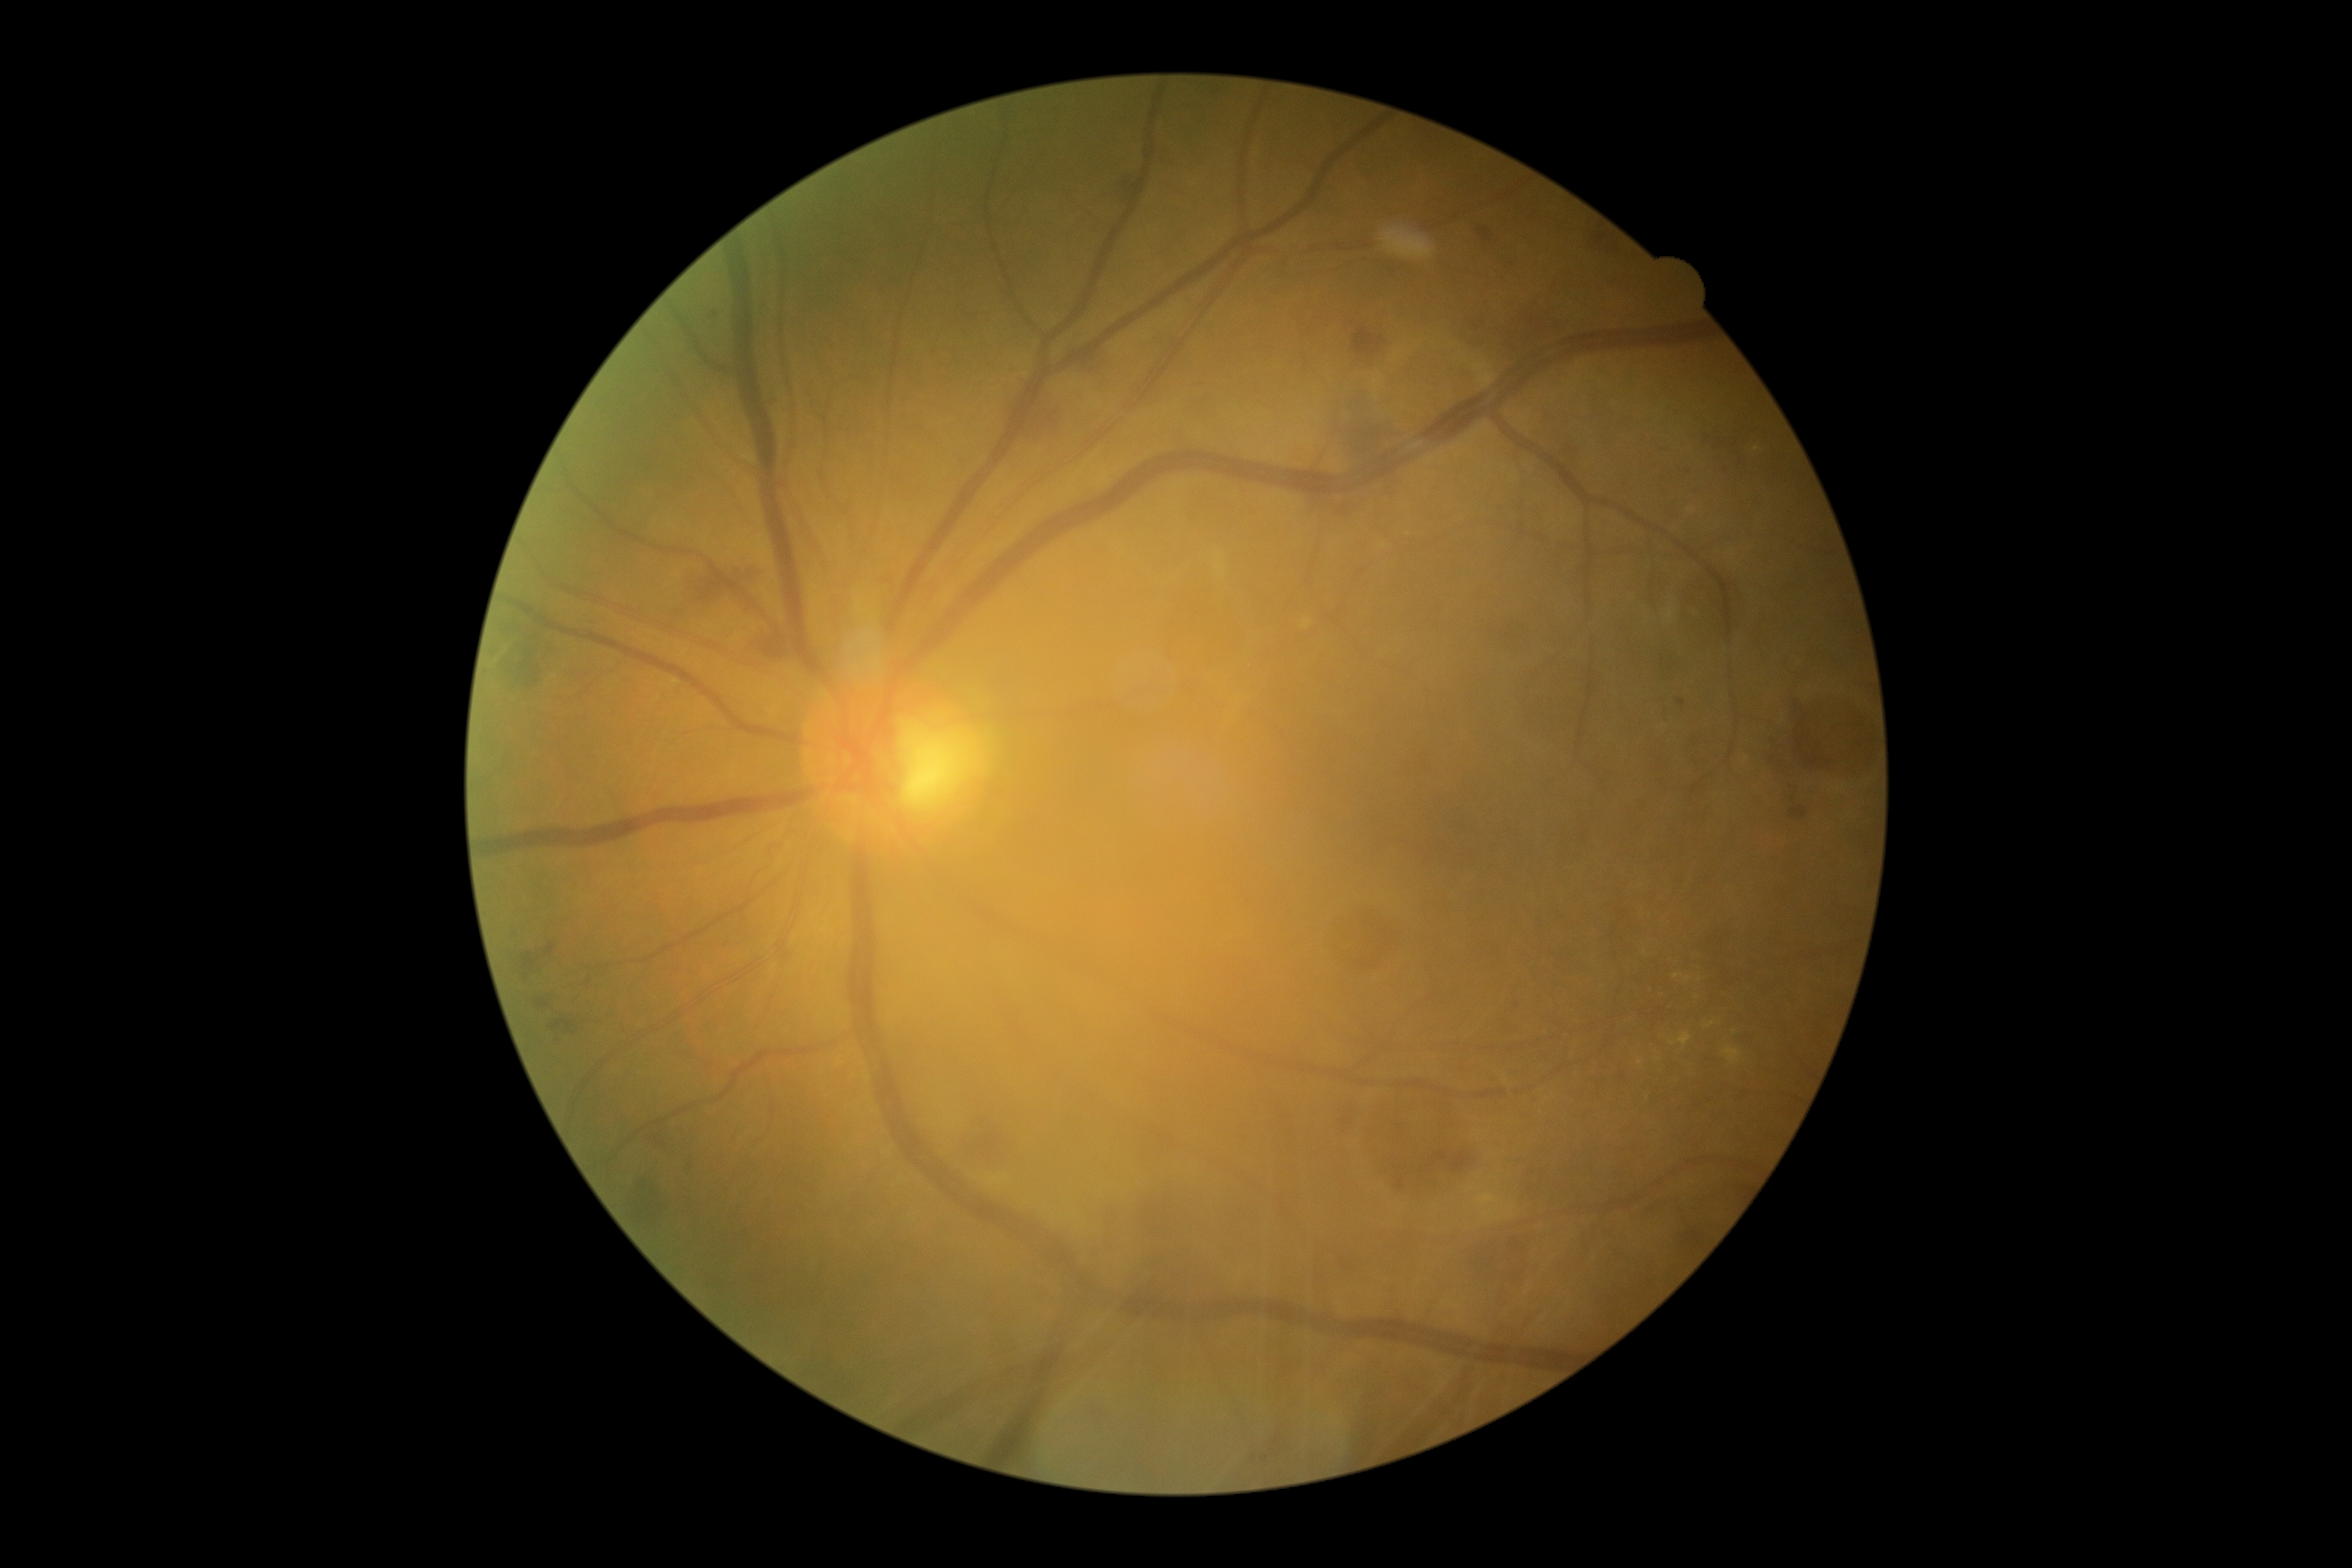 DR: grade 2; non-proliferative diabetic retinopathy
Lesions identified (partial list):
HEs (subset): <region>1449, 1153, 1476, 1173</region>; <region>1342, 388, 1378, 465</region>; <region>534, 995, 556, 1012</region>; <region>1791, 704, 1835, 778</region>; <region>756, 627, 790, 661</region>; <region>981, 1120, 991, 1127</region>; <region>518, 941, 560, 983</region>; <region>632, 1180, 668, 1227</region>; <region>651, 1125, 666, 1146</region>; <region>1032, 403, 1060, 441</region>
Small HEs near pt(750, 663)